45° field of view, image size 2048x1536 — 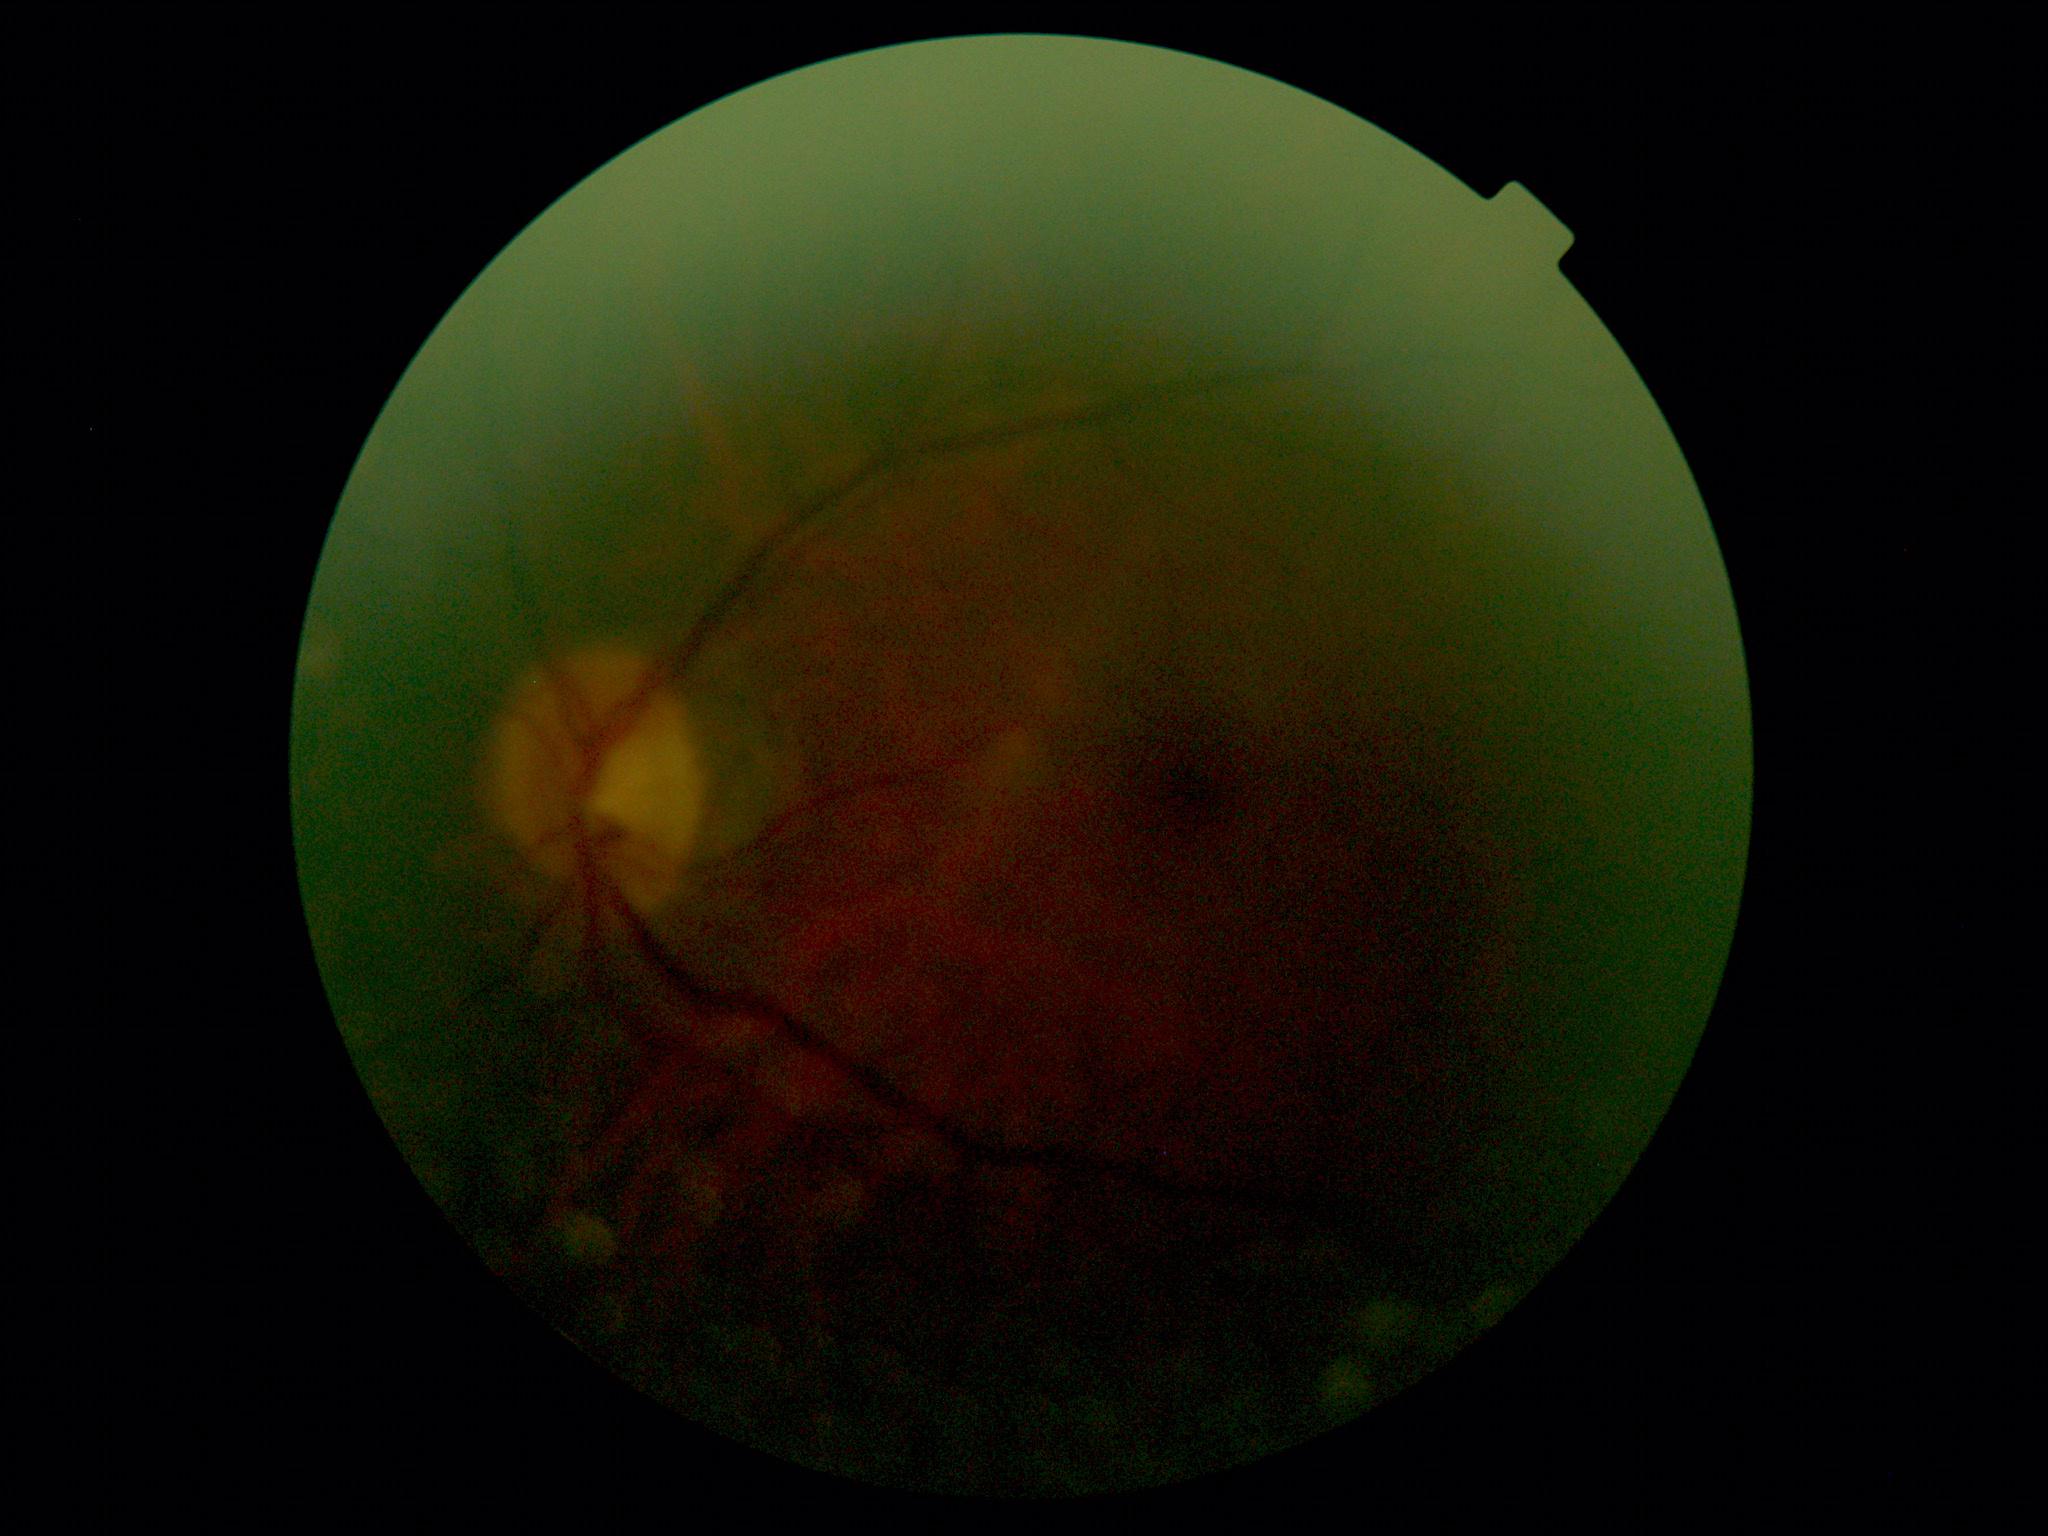 Retinopathy grade is no apparent diabetic retinopathy (0).